RetCam wide-field infant fundus image
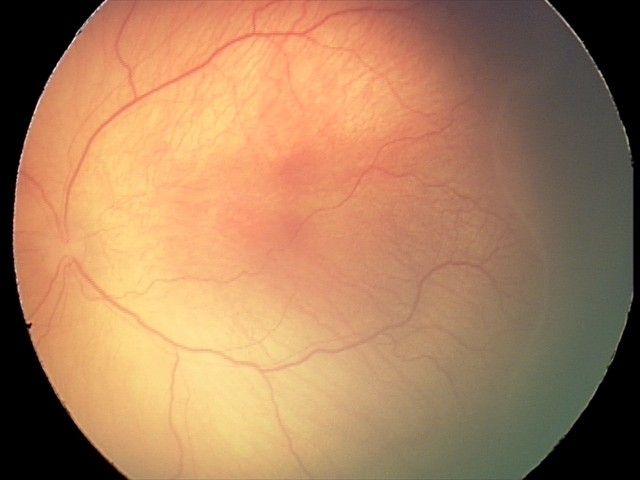 Screening: retinopathy of prematurity (ROP) stage 2.